Clarity RetCam 3, 130° FOV; wide-field fundus photograph of an infant — 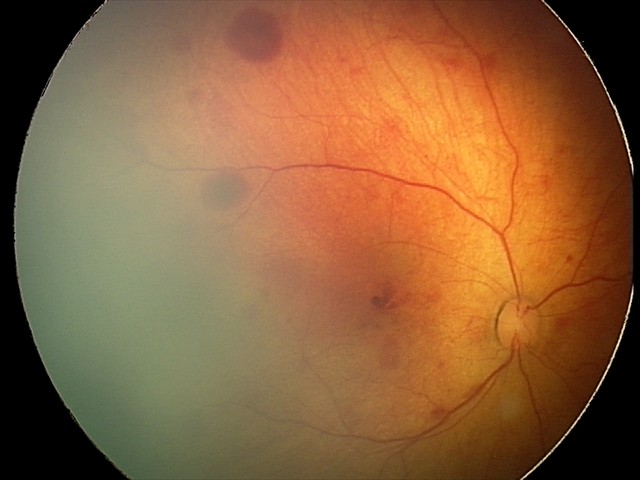

Screening examination consistent with retinal hemorrhages.